Nonmydriatic. Image size 848x848. Davis DR grading. Acquired with a NIDEK AFC-230. 45 degree fundus photograph
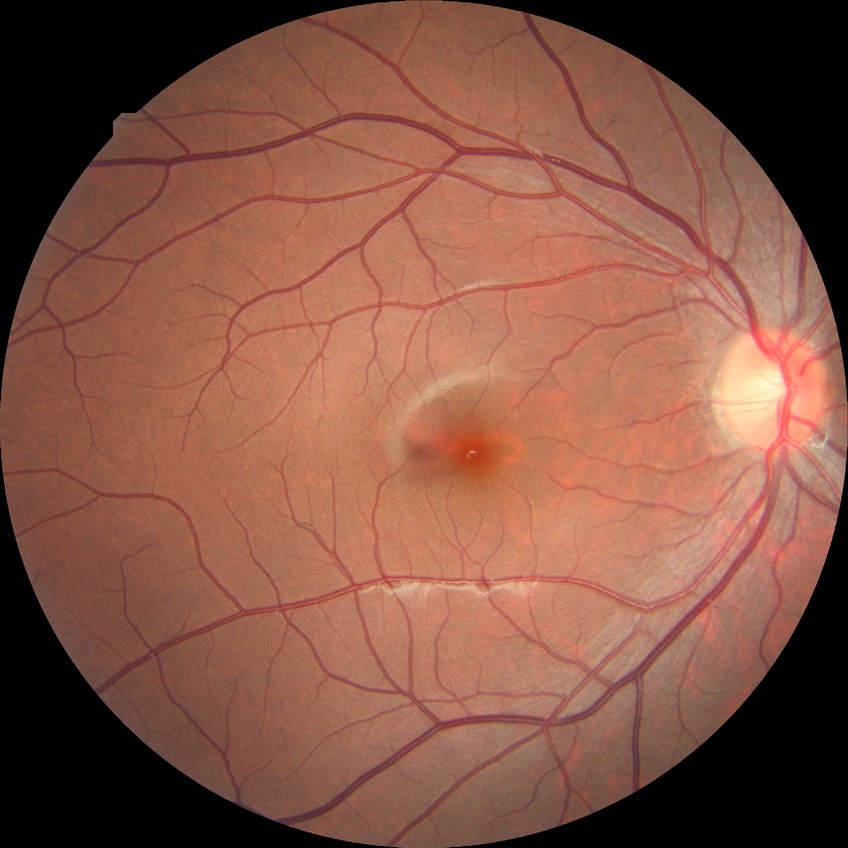

davis_grade: no diabetic retinopathy (NDR)